Image size 2352x1568 — 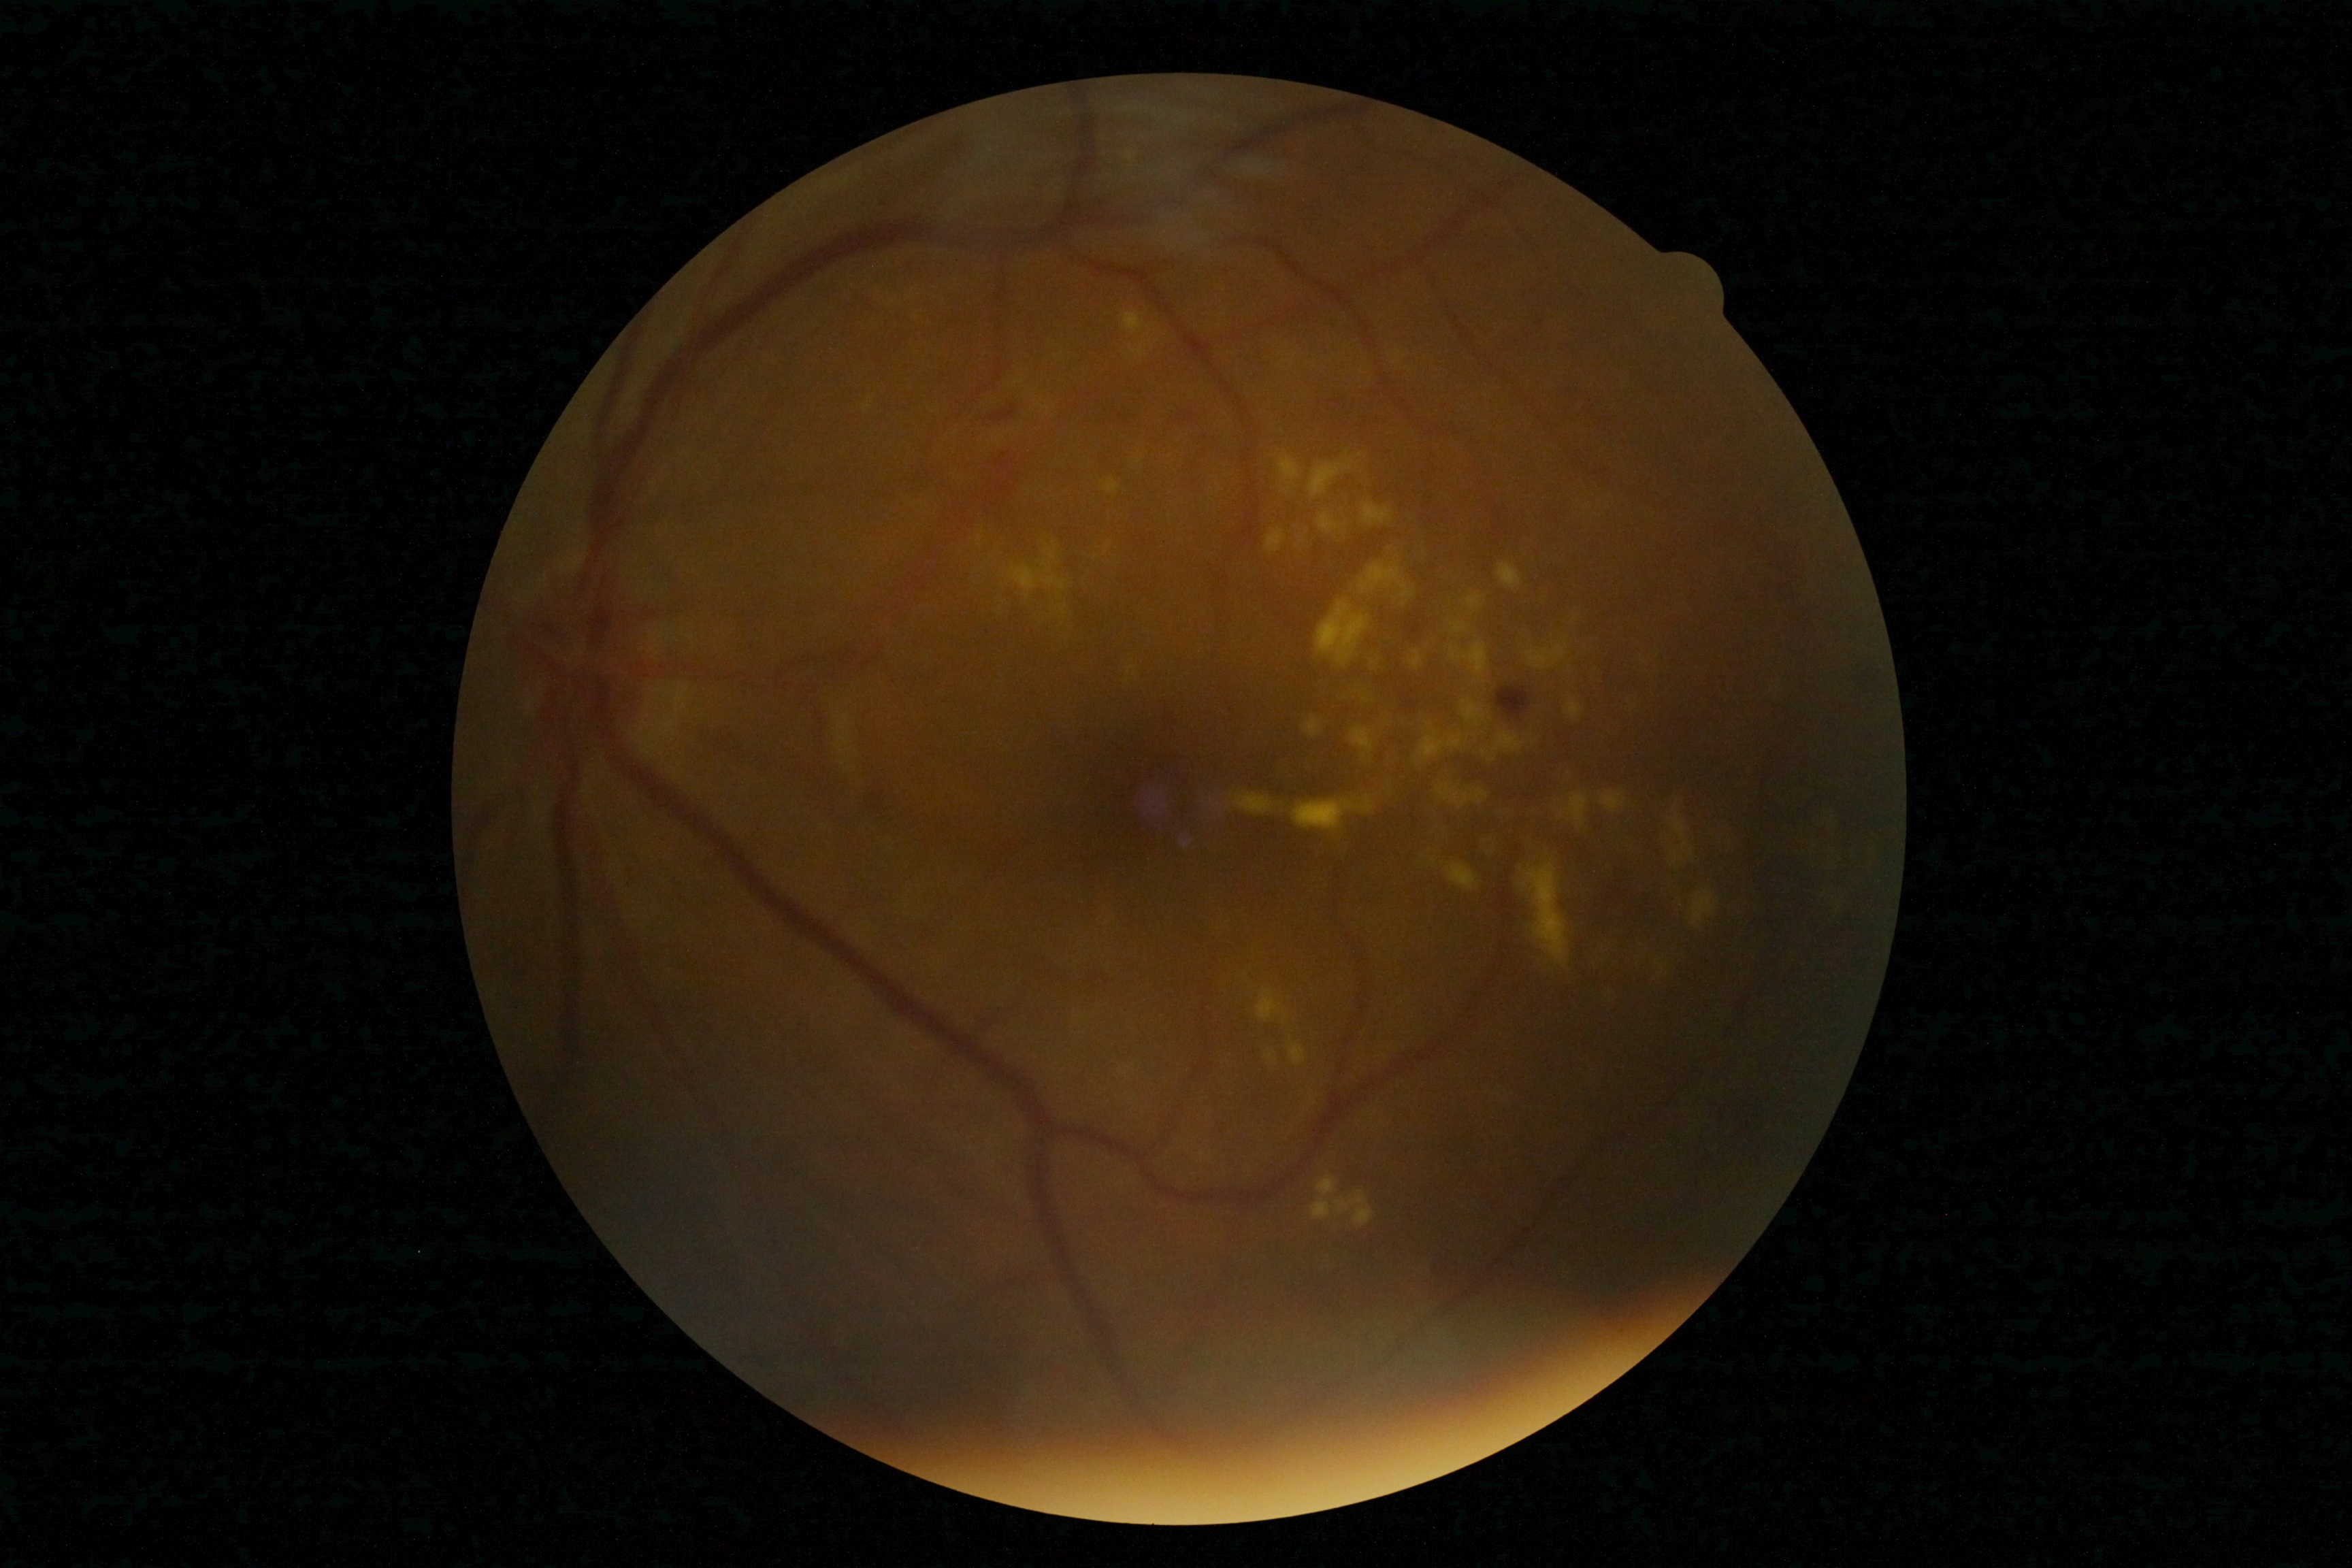
Diabetic retinopathy (DR): 2/4.